Graded on the modified Davis scale:
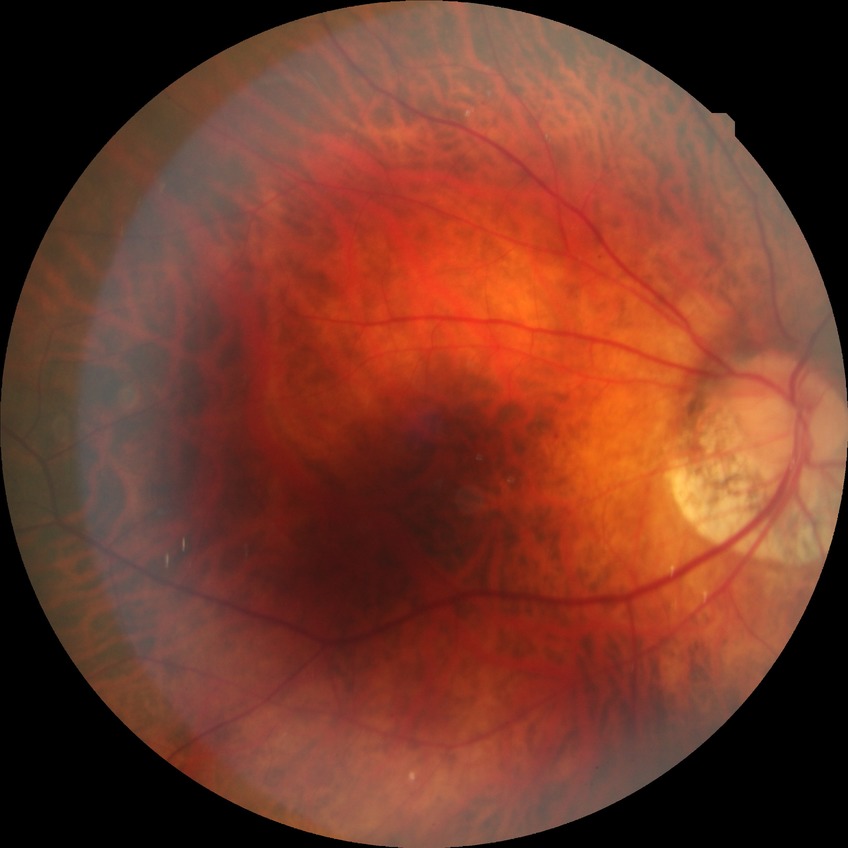 Diabetic retinopathy (DR): NDR (no diabetic retinopathy).